Color fundus photograph, camera: NIDEK AFC-230:
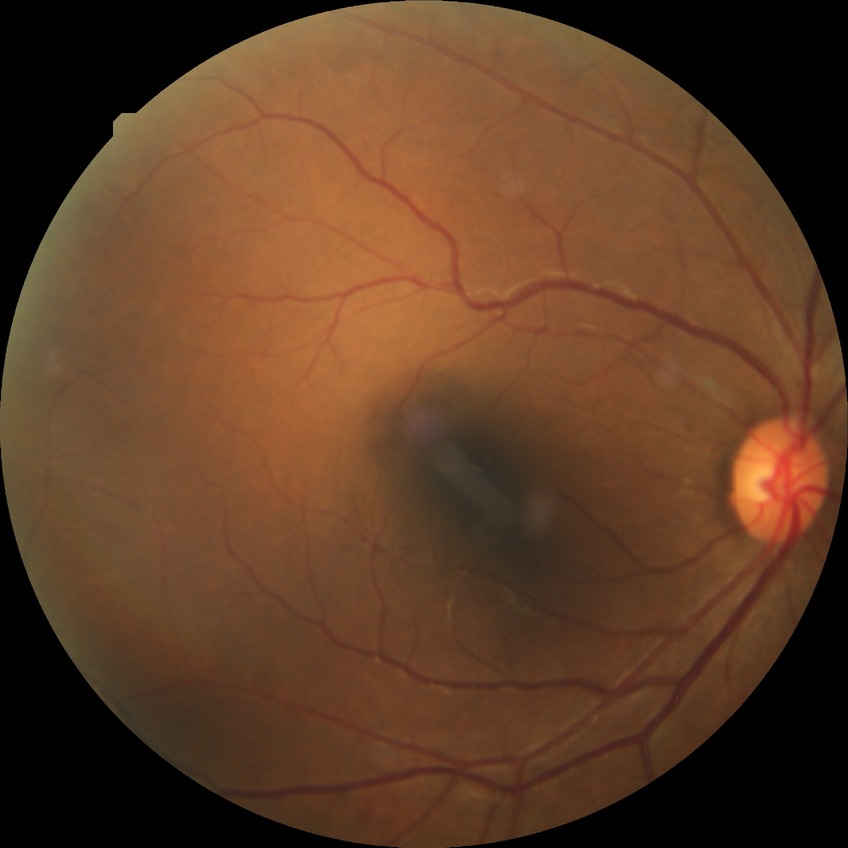
davis_grade: simple diabetic retinopathy